Modified Davis grading, image size 848x848.
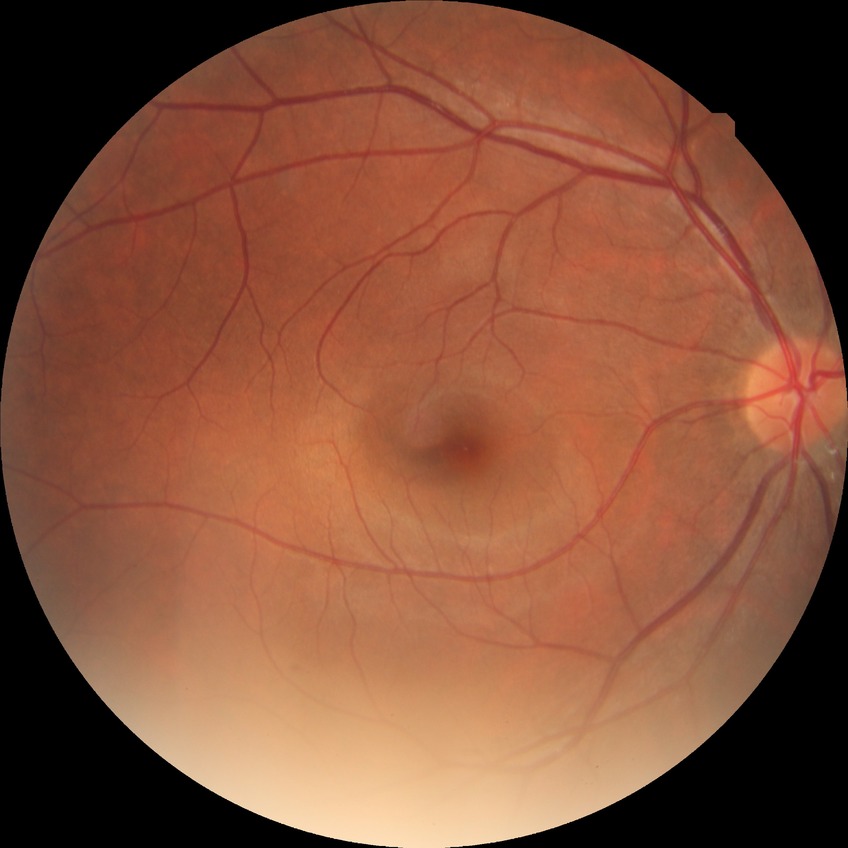
diabetic retinopathy (DR) = NDR (no diabetic retinopathy).